848x848px, color fundus photograph — 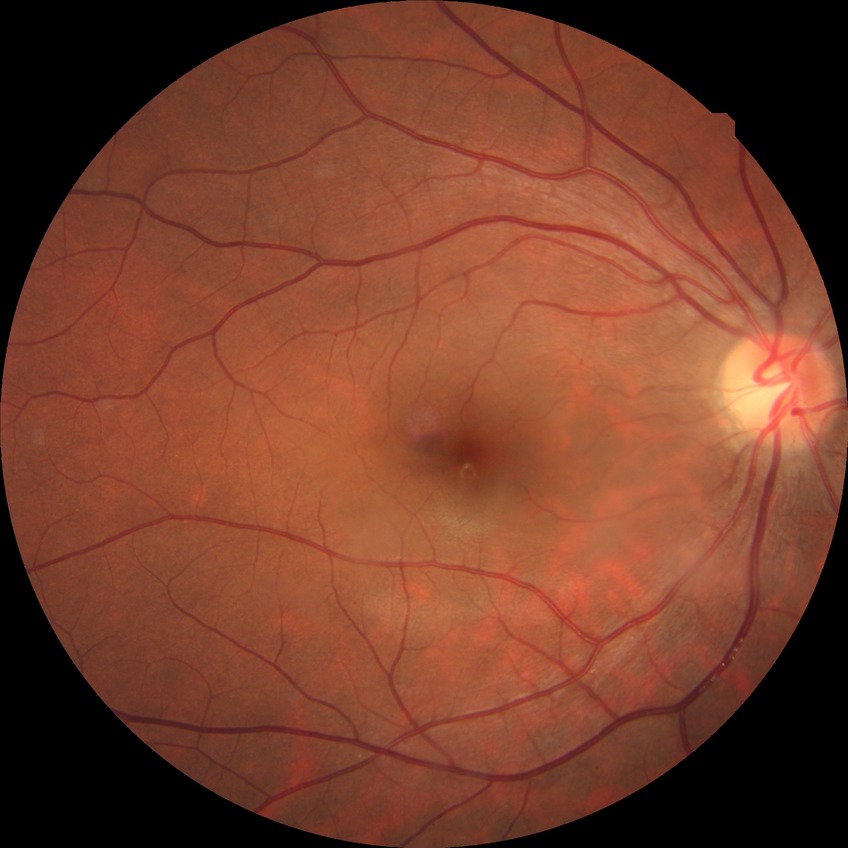
modified Davis classification: no diabetic retinopathy.